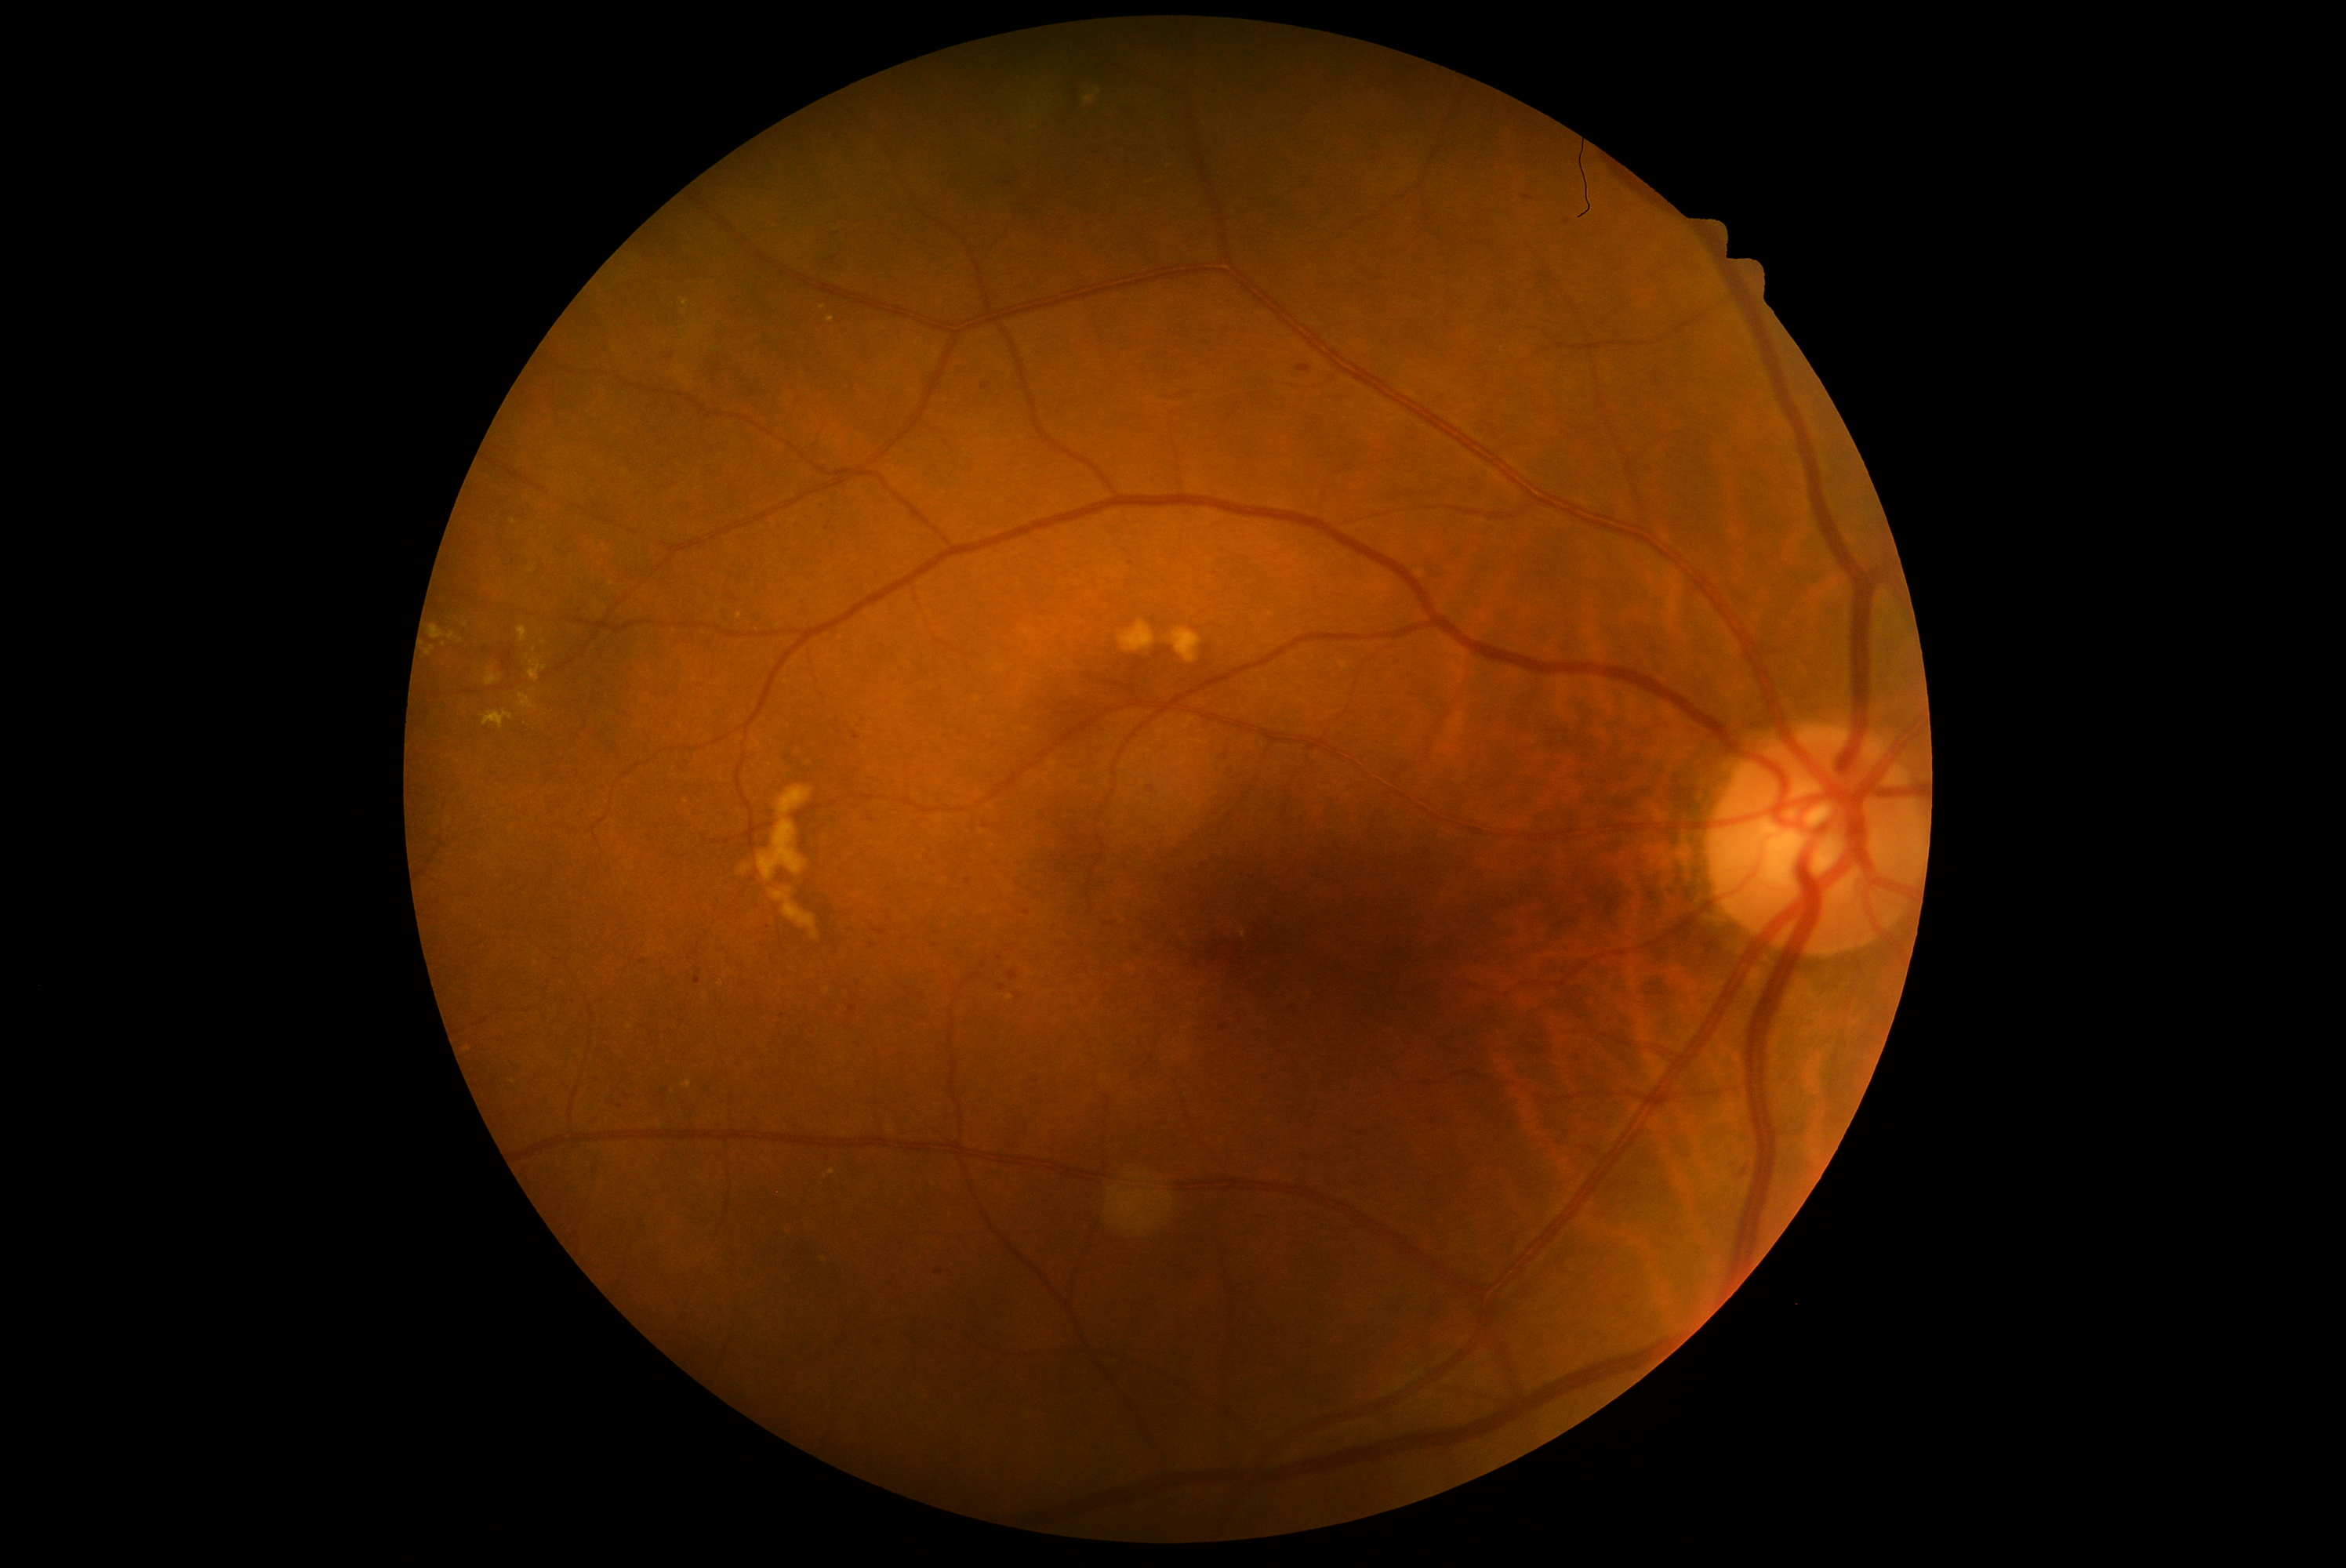

Diabetic retinopathy (DR): moderate NPDR (grade 2); non-proliferative diabetic retinopathy
Representative lesions:
• hard exudates (EXs) (subset): left=528, top=659, right=548, bottom=683, left=518, top=626, right=528, bottom=644, left=683, top=299, right=689, bottom=307, left=1084, top=90, right=1102, bottom=104, left=485, top=672, right=498, bottom=686
• Smaller EXs around Point(534, 690), Point(534, 650), Point(544, 644), Point(465, 625), Point(531, 571), Point(612, 585)
• hemorrhages (HEs) (subset): left=1389, top=176, right=1398, bottom=184, left=568, top=998, right=578, bottom=1007, left=1146, top=786, right=1157, bottom=794, left=1120, top=103, right=1141, bottom=122, left=1726, top=1158, right=1756, bottom=1181, left=1080, top=222, right=1094, bottom=234, left=1199, top=339, right=1211, bottom=349, left=871, top=1335, right=887, bottom=1352, left=852, top=733, right=860, bottom=741
• Smaller HEs around Point(838, 268), Point(1017, 998), Point(865, 249), Point(644, 962), Point(1375, 158), Point(1567, 222), Point(864, 720)